Pediatric retinal photograph (wide-field).
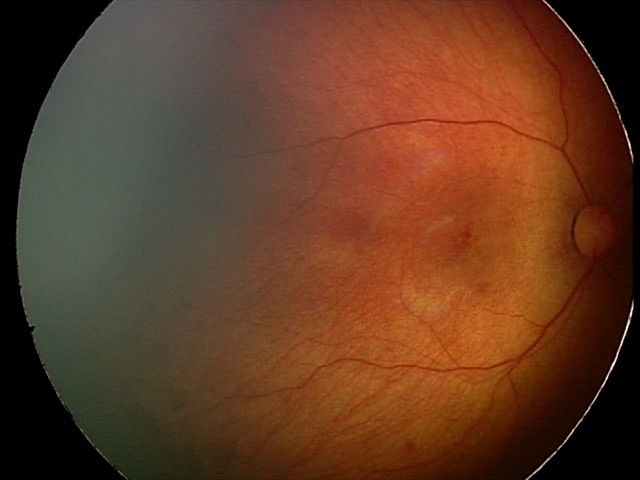

Assessment: retinal hemorrhages.